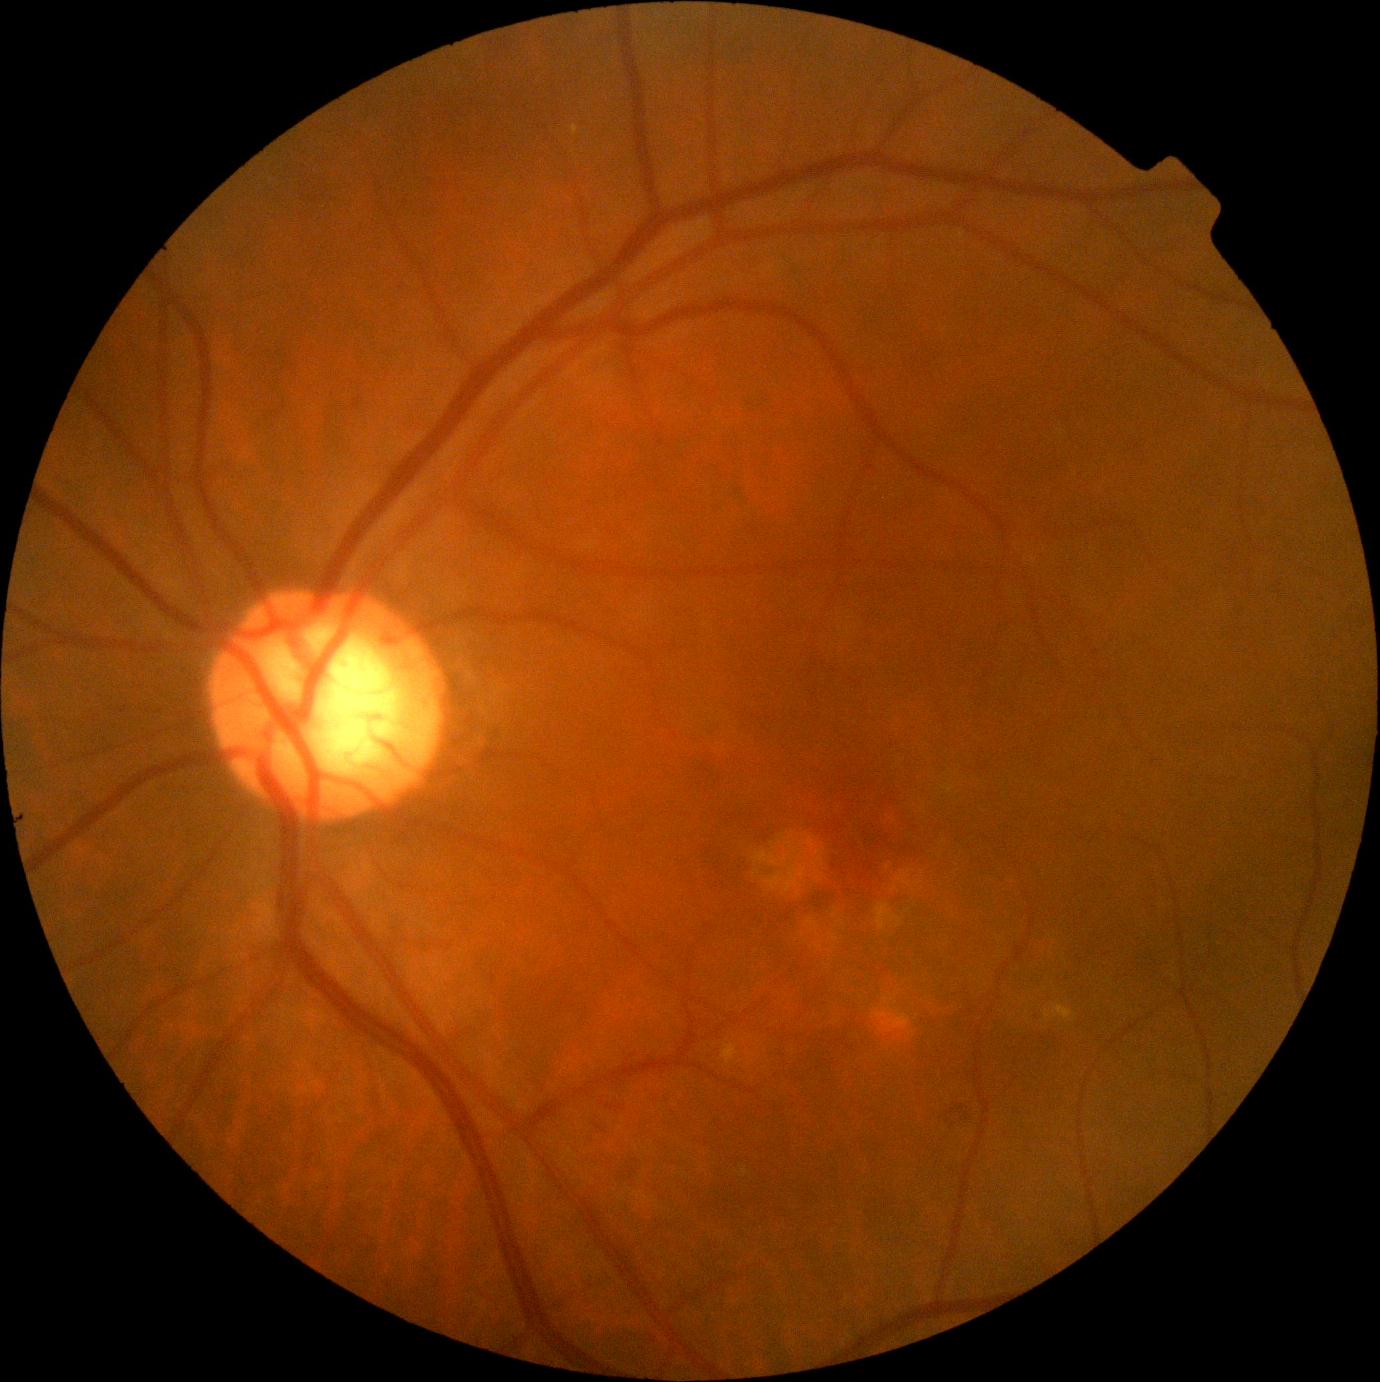

DR severity is grade 2 (moderate NPDR).